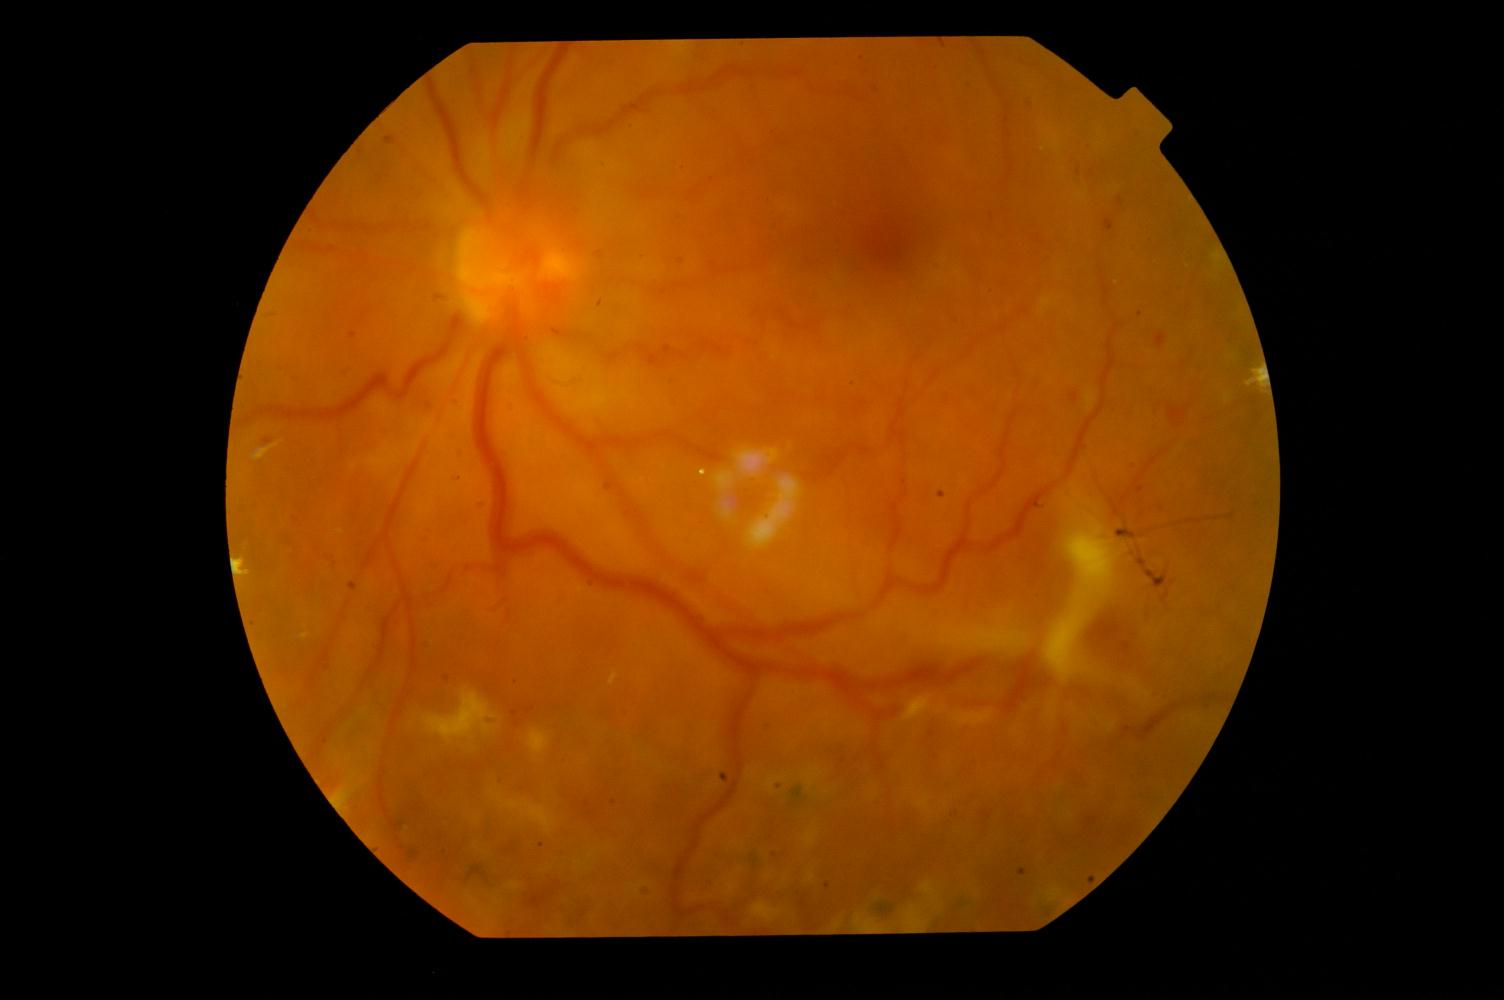

Findings: diabetic retinopathy.